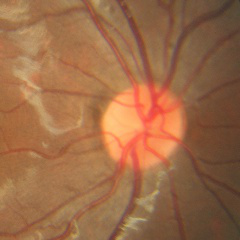
No signs of glaucoma.